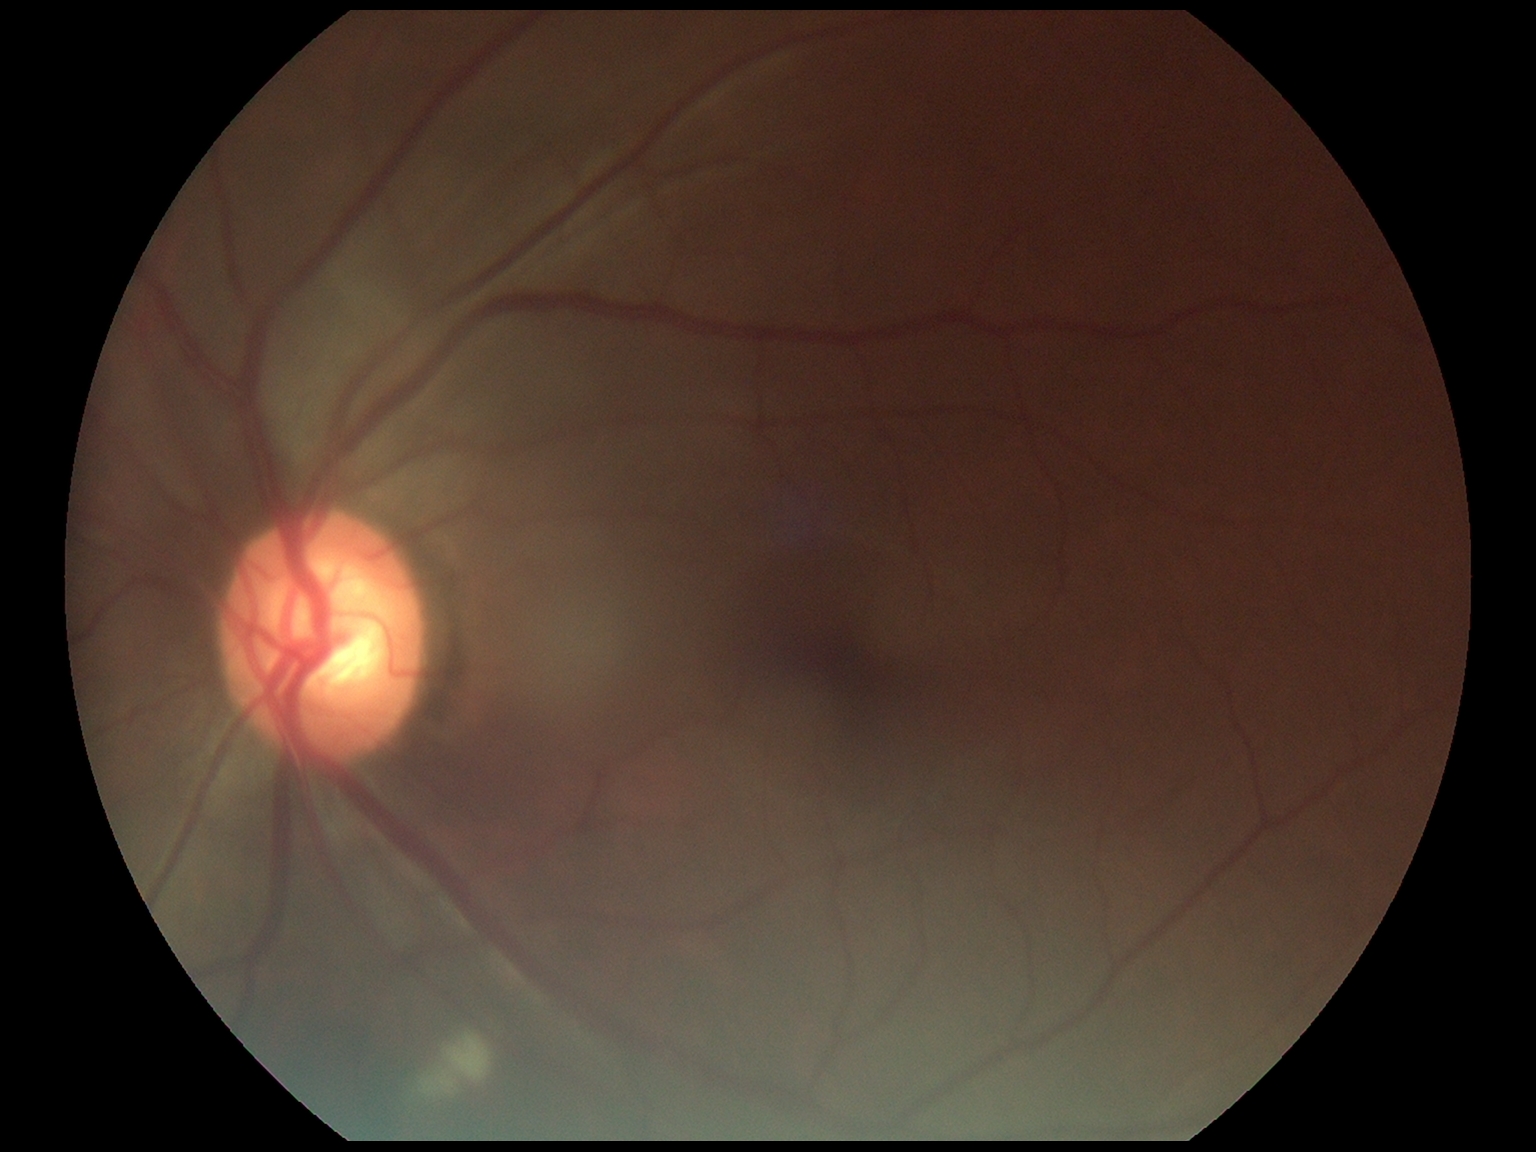 DR = 2/4 — more than just microaneurysms but less than severe NPDR.